50-degree field of view:
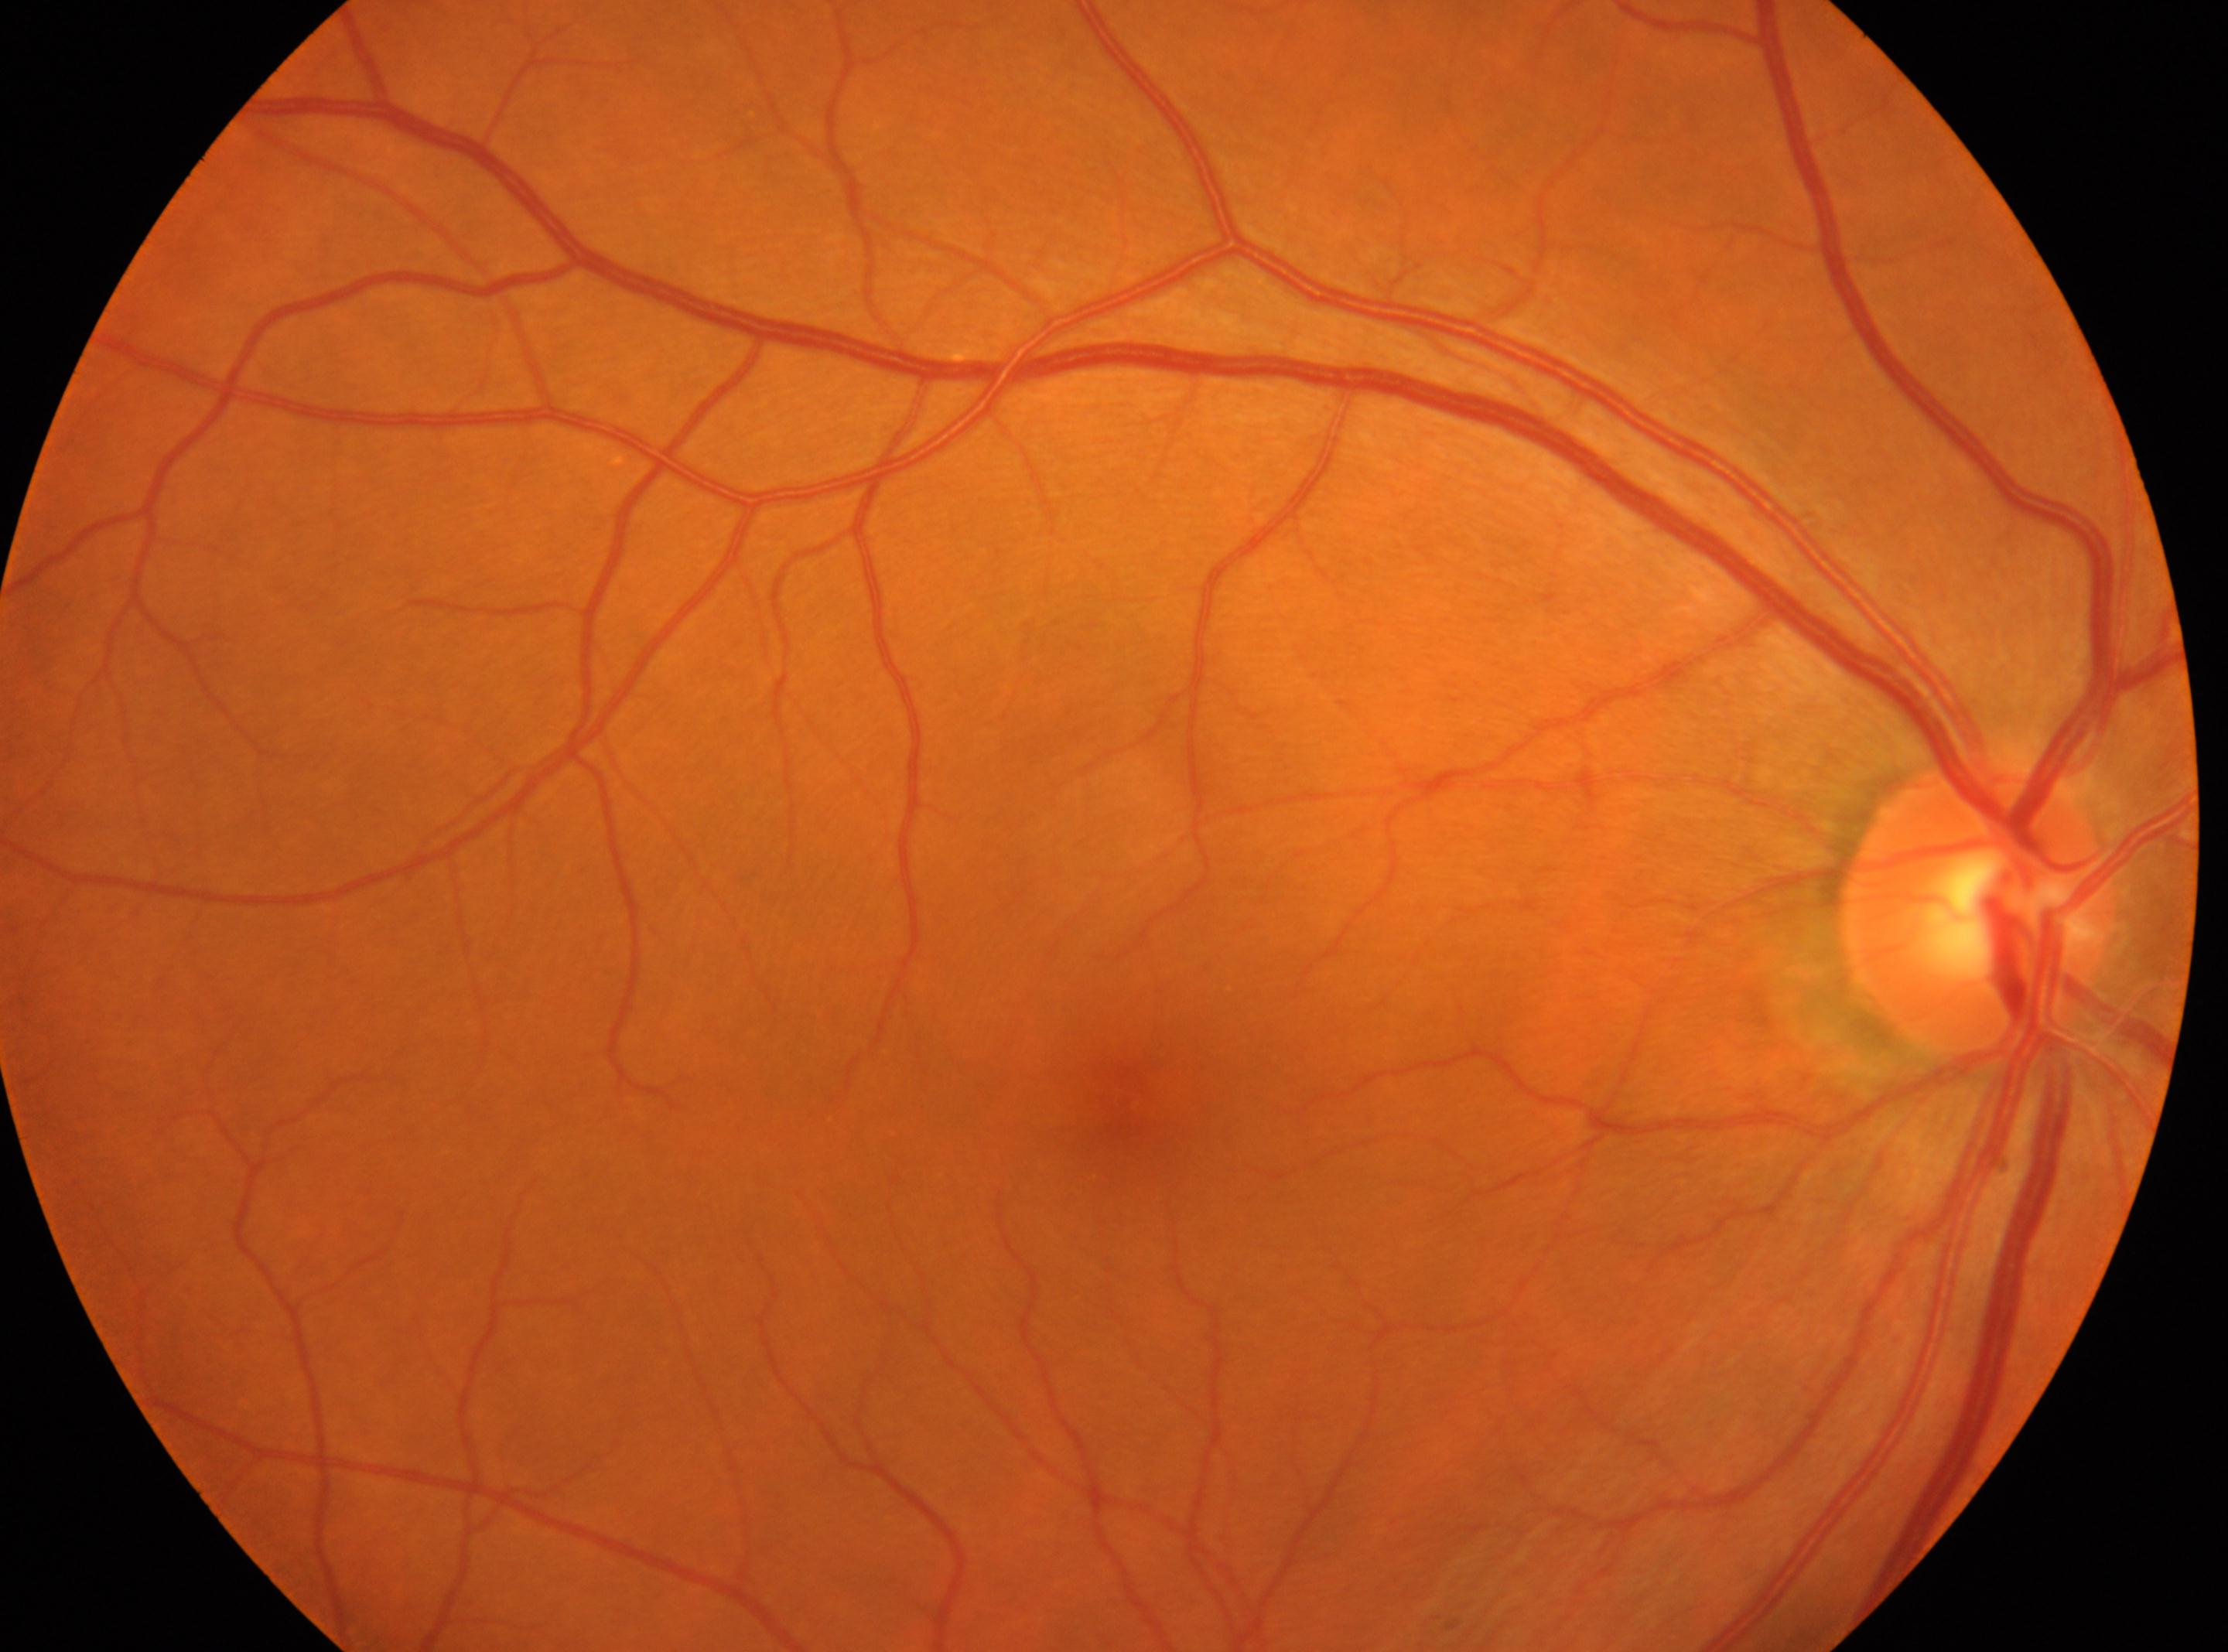

Q: Locate the fovea.
A: (1136,1109)
Q: What is the laterality?
A: oculus dexter
Q: DR stage?
A: grade 0
Q: Locate the optic disc.
A: (1976,906)